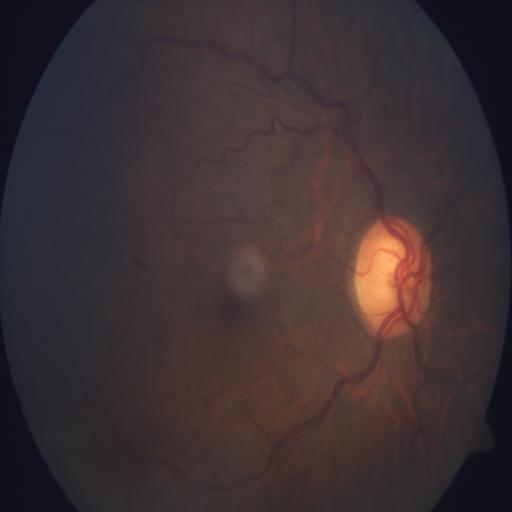 Findings: media haze (MH) | hemorrhagic retinopathy (HR).